512x512 · retinal fundus photograph:
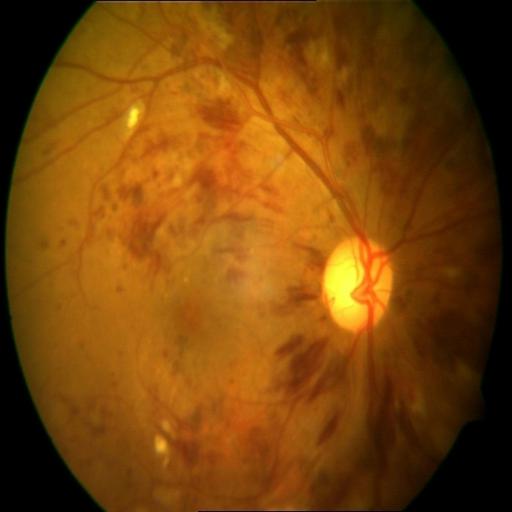 Impression: central retinal vein occlusion (CRVO).